Retinal fundus photograph:
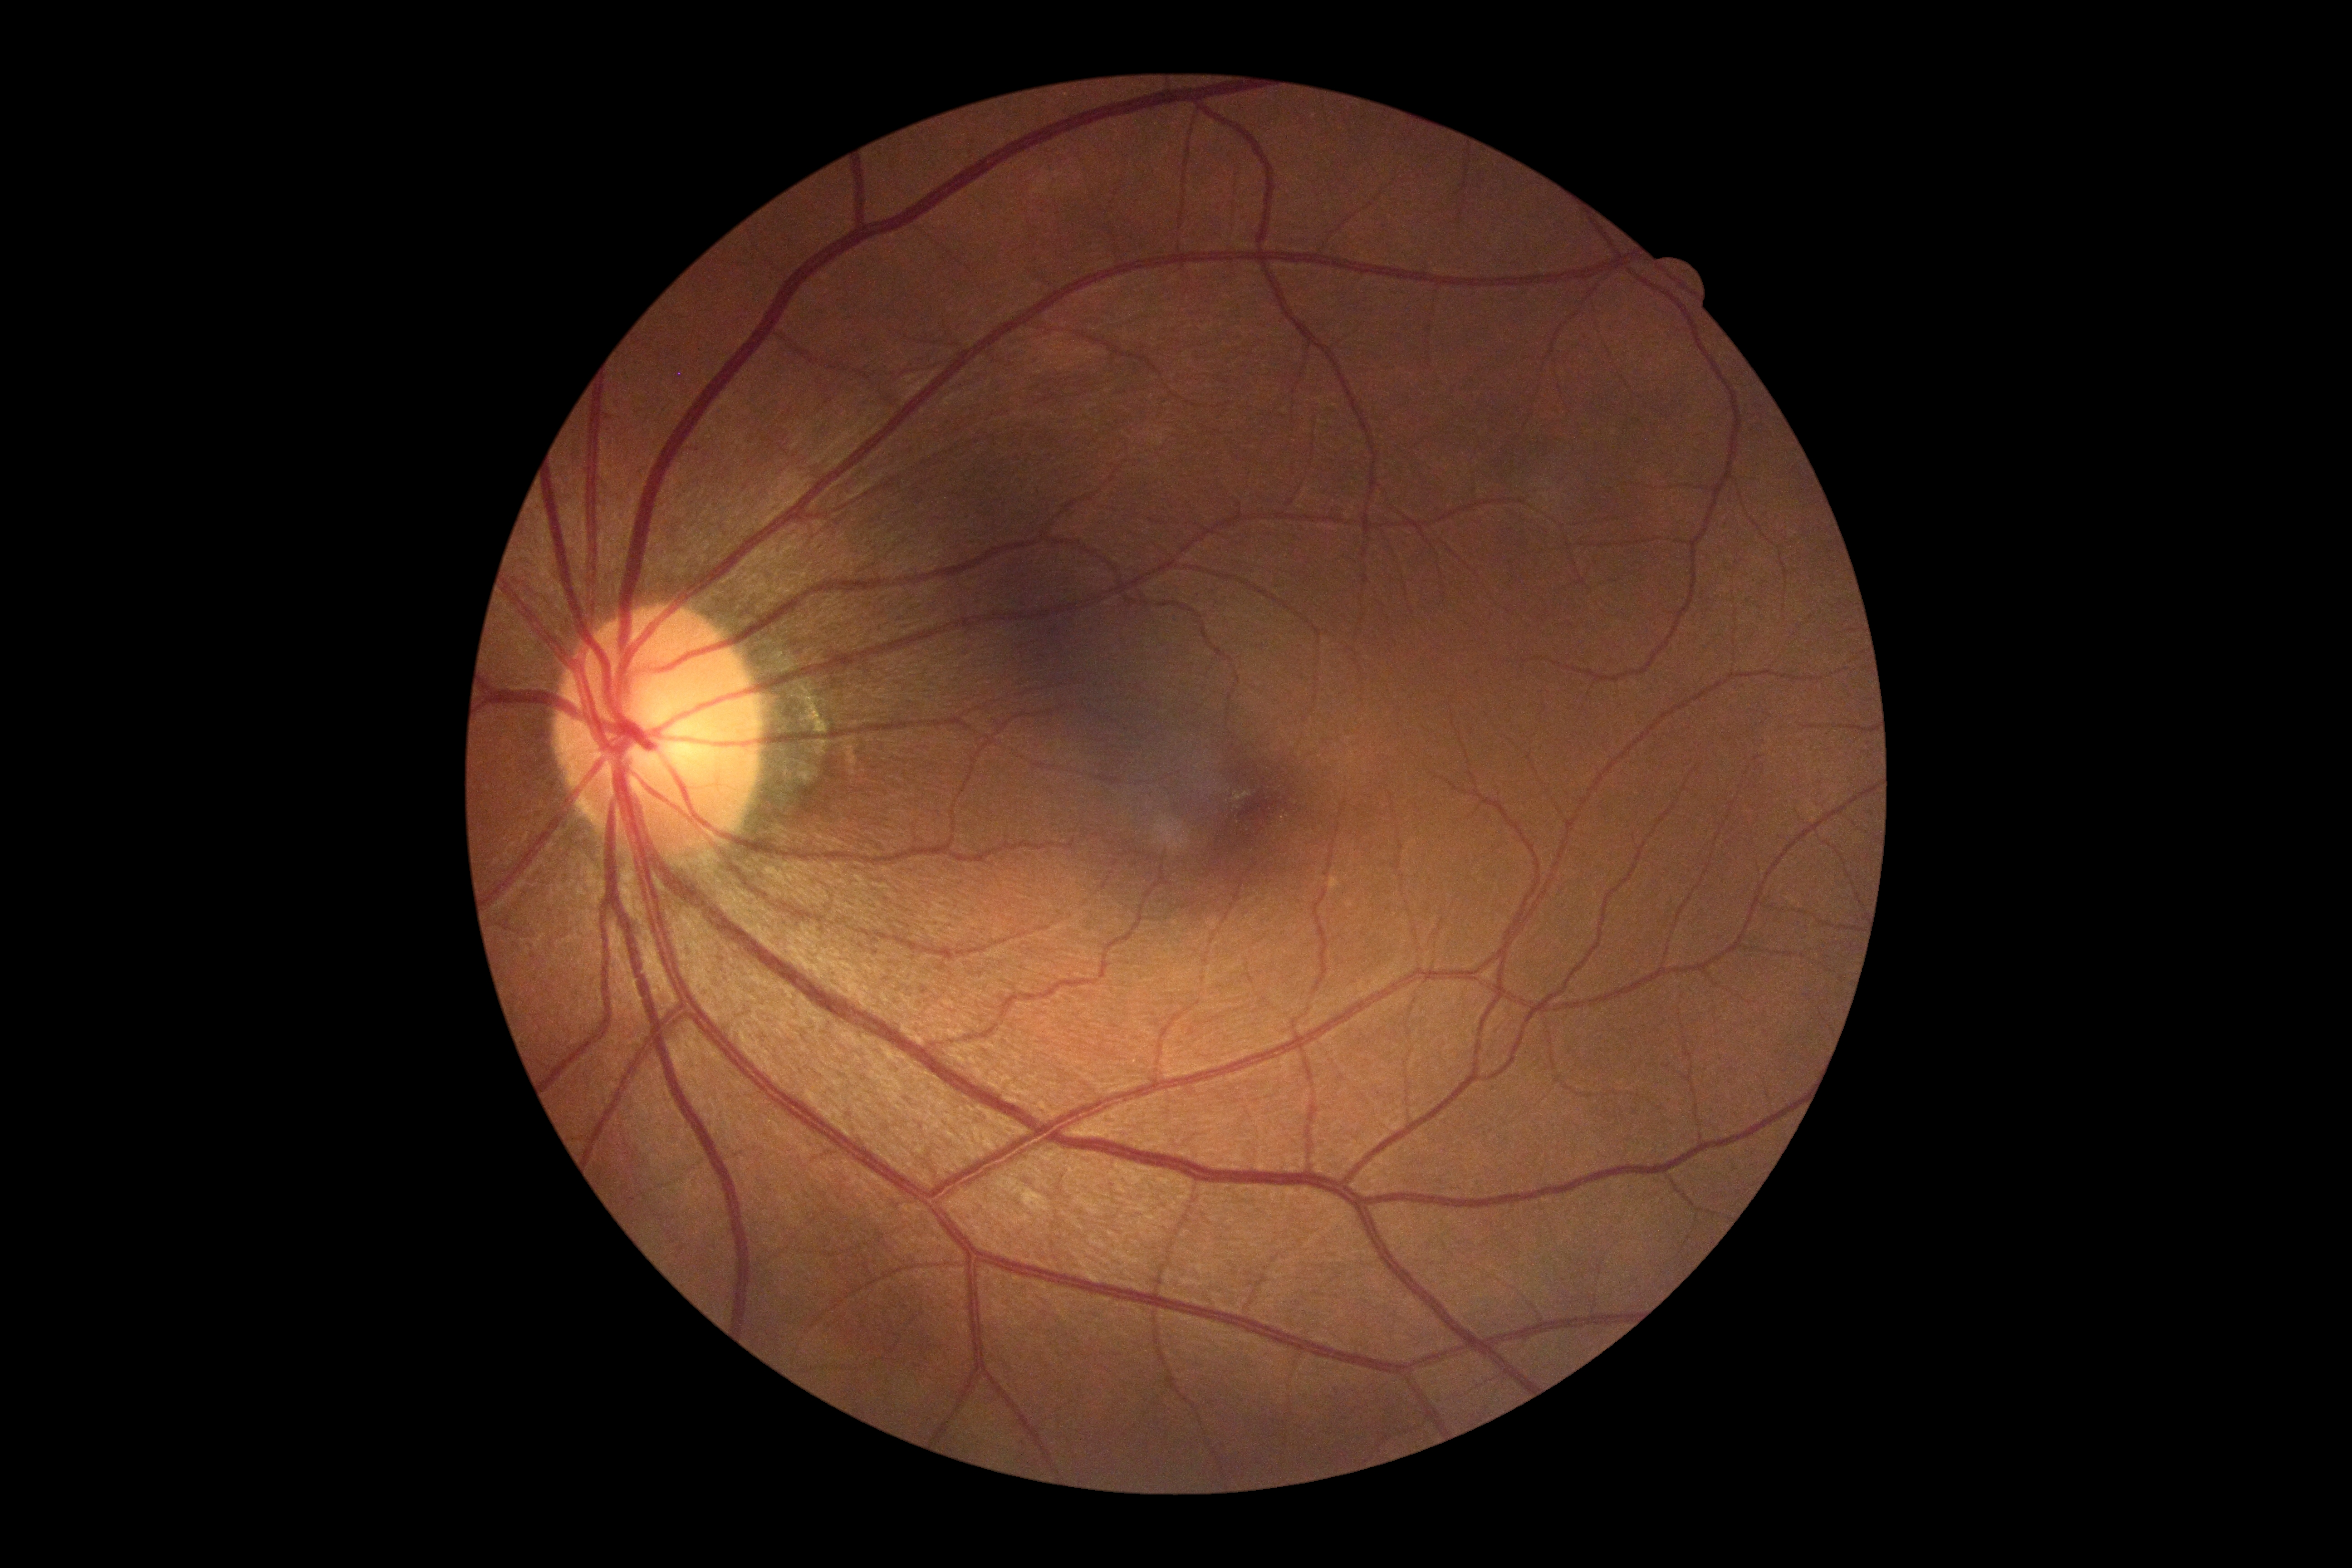 Diabetic retinopathy (DR) is grade 0 (no apparent retinopathy).